45° field of view; 2212 by 1659 pixels
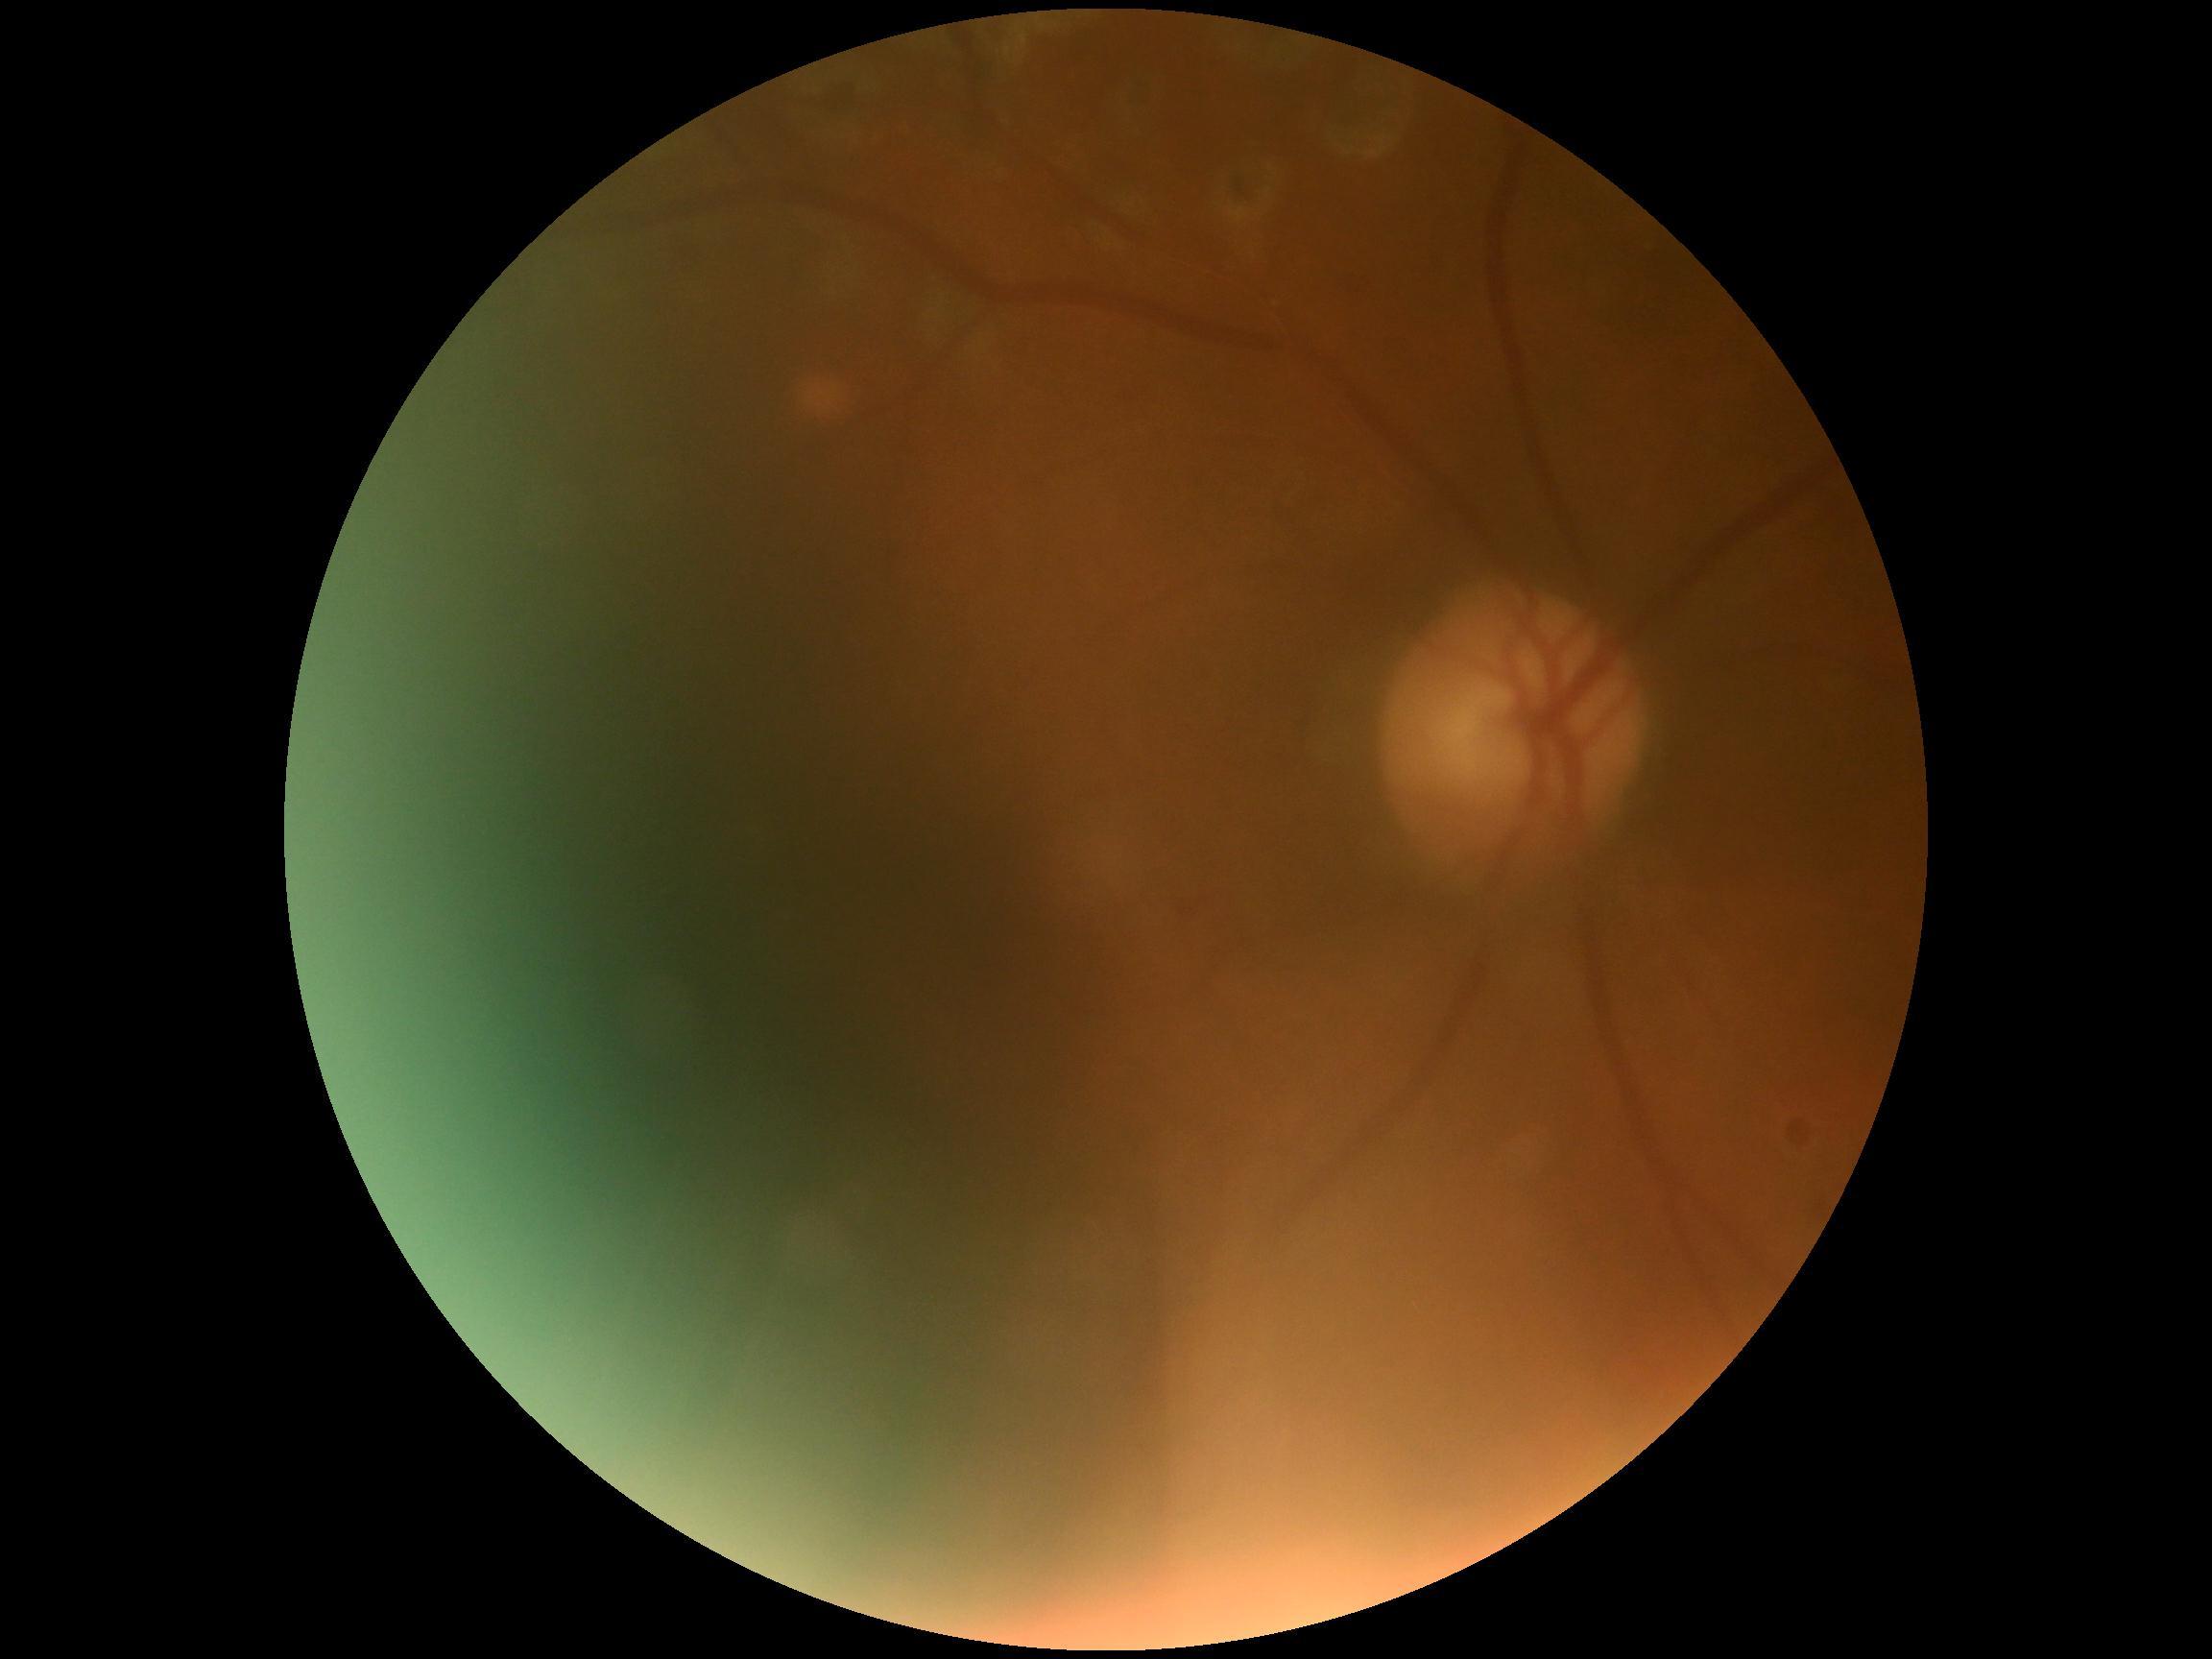 quality: below grading threshold
dr_grade: ungradable